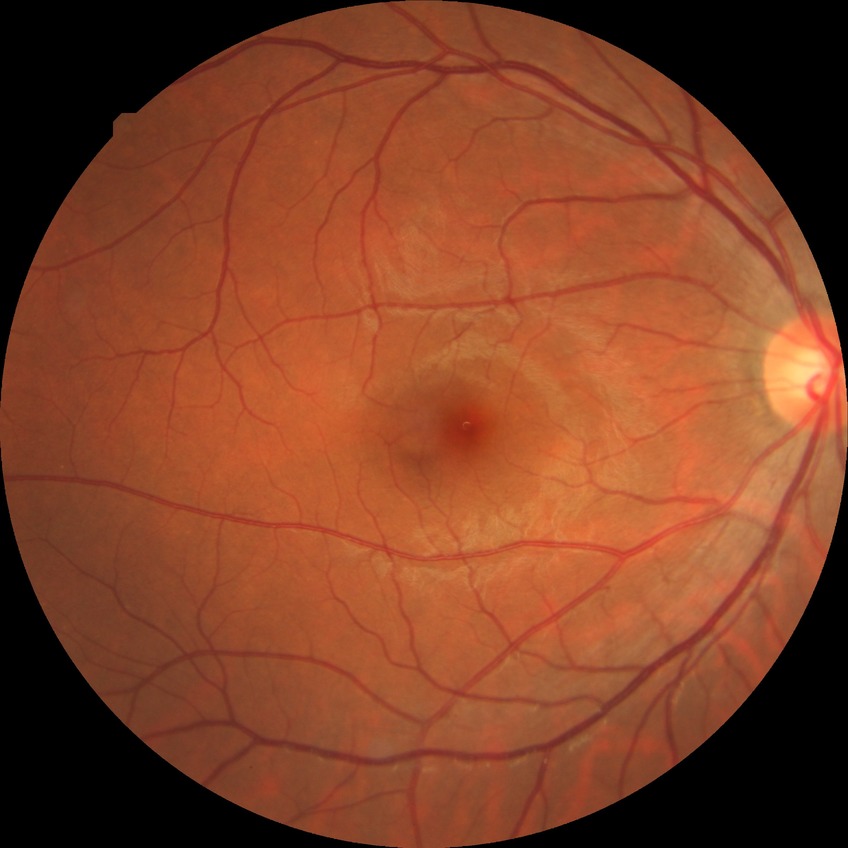
DR impression = no DR findings; Davis DR grade = NDR.